Retinal fundus photograph
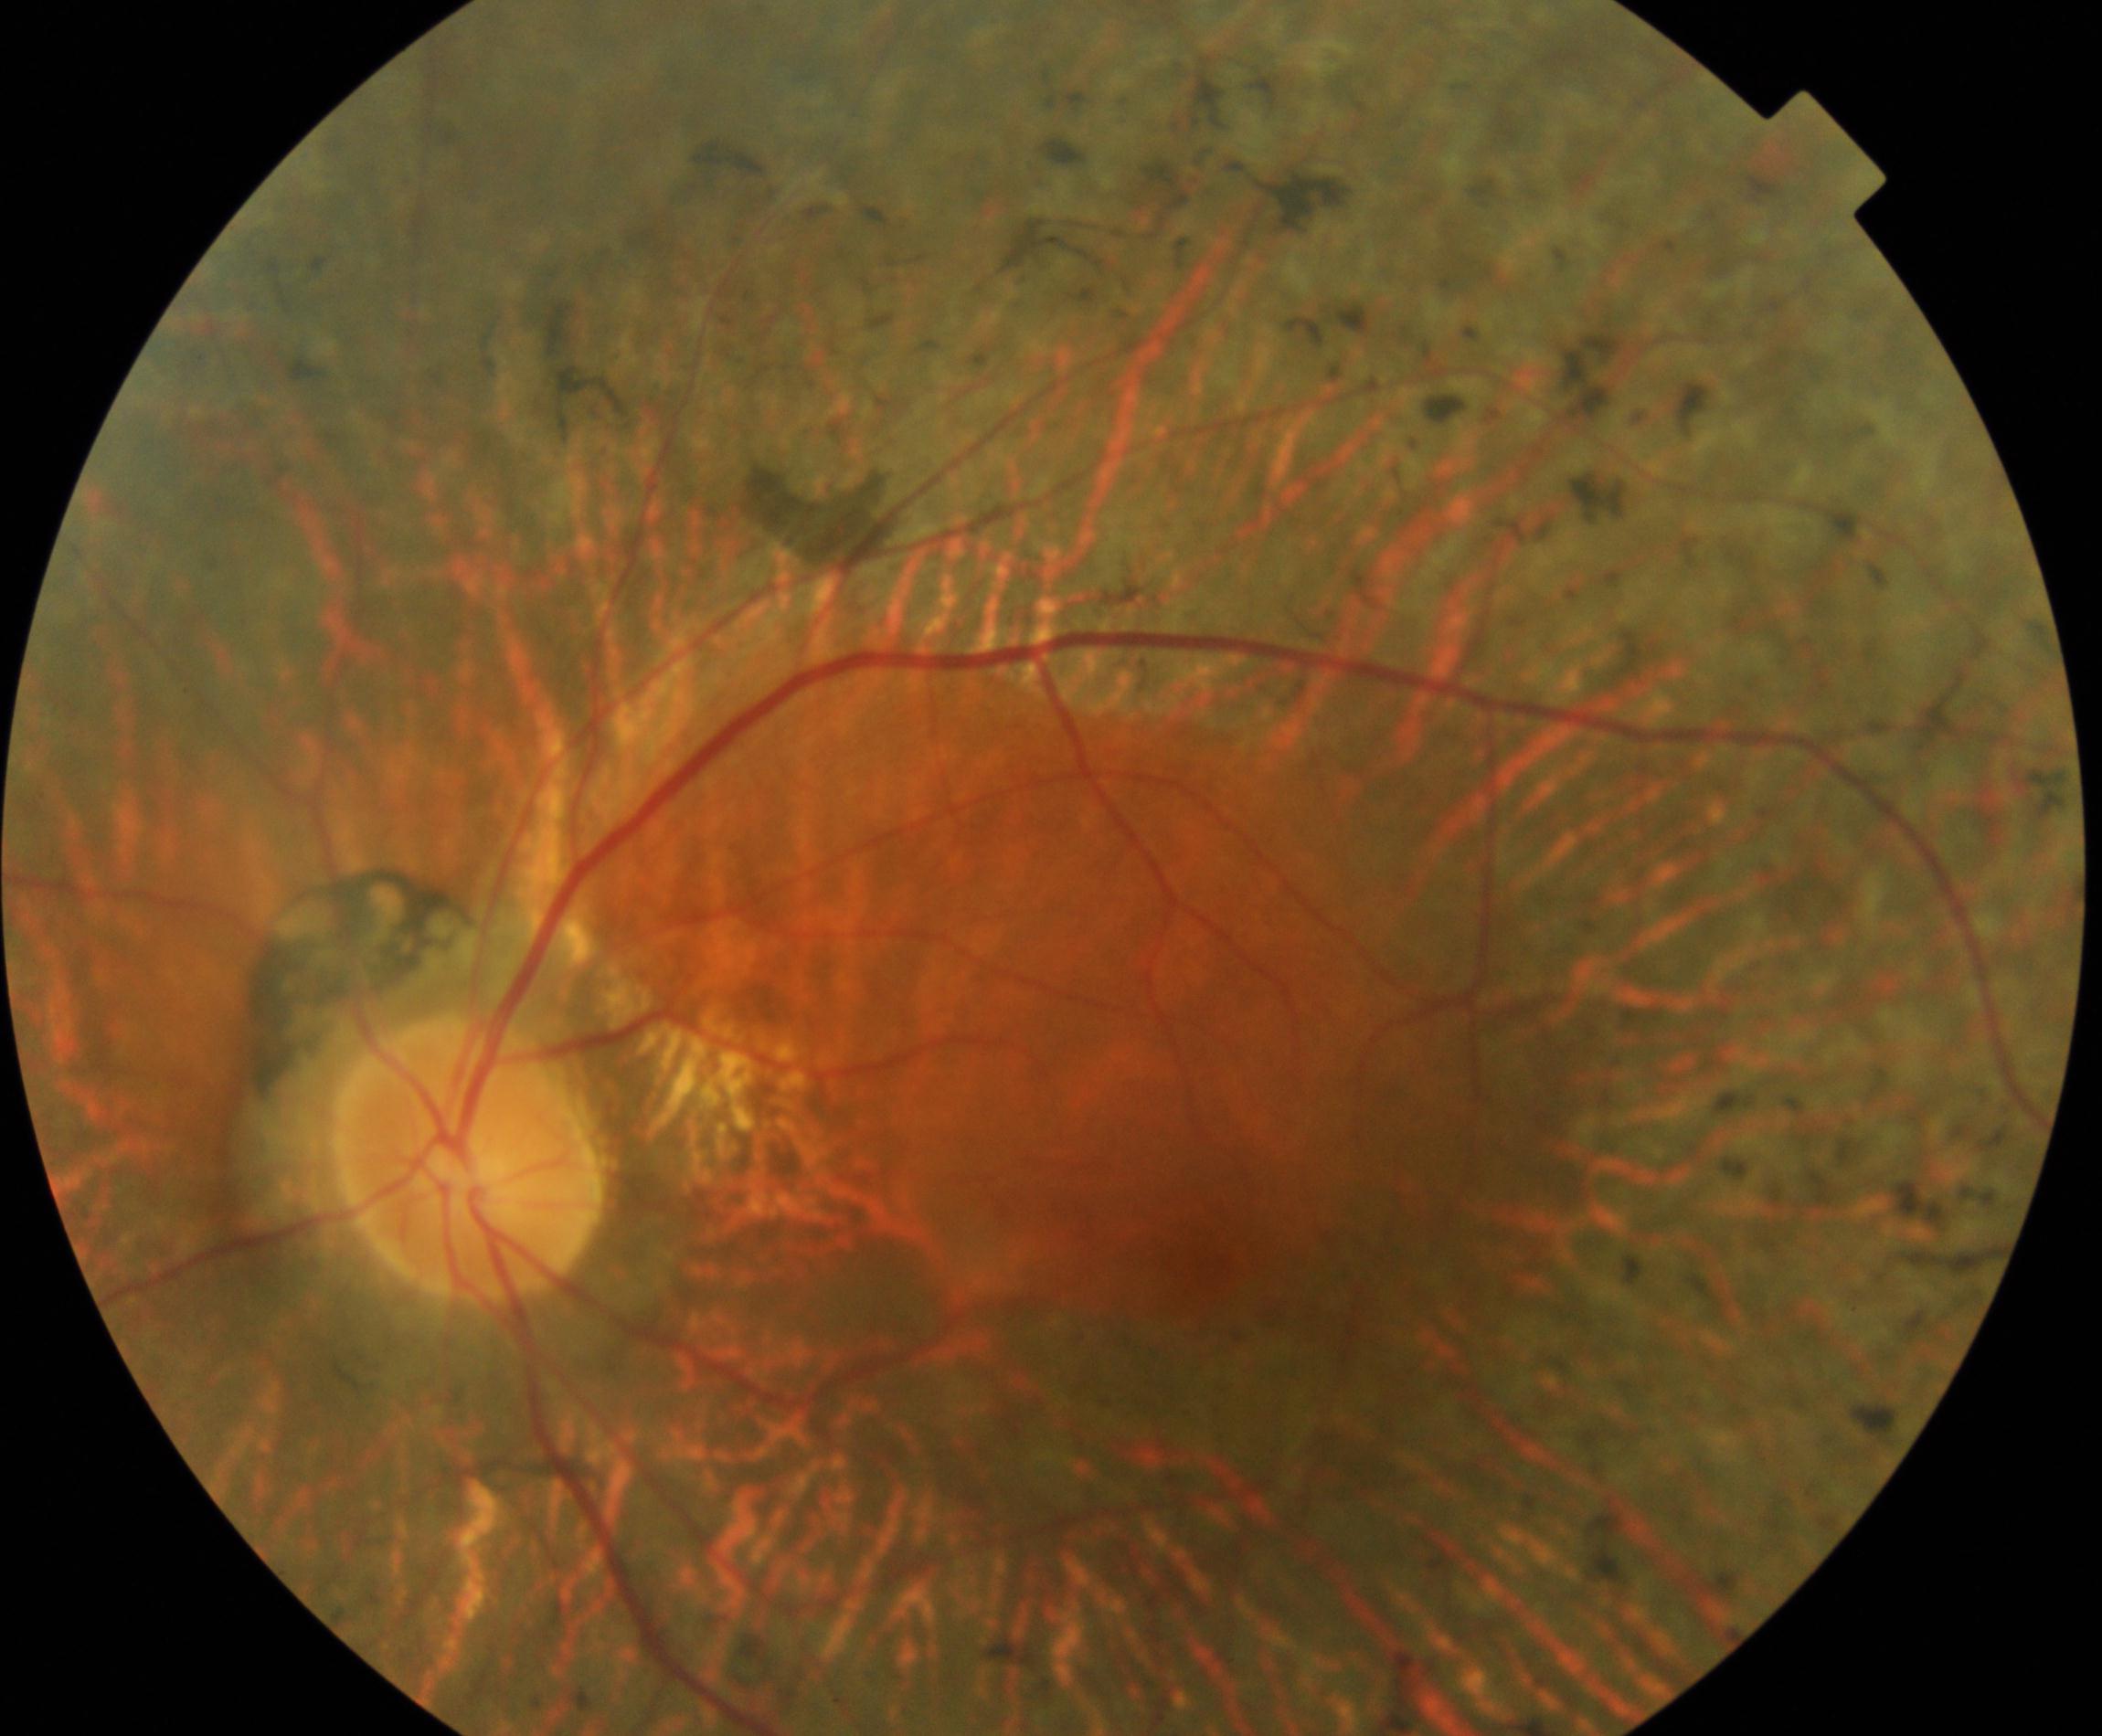 Findings: retinitis pigmentosa. Characterized by mid-peripheral retinal pigment epithelium atrophy with bone-spicule perivascular pigmentation, arteriolar attenuation, and waxy disc pallor.